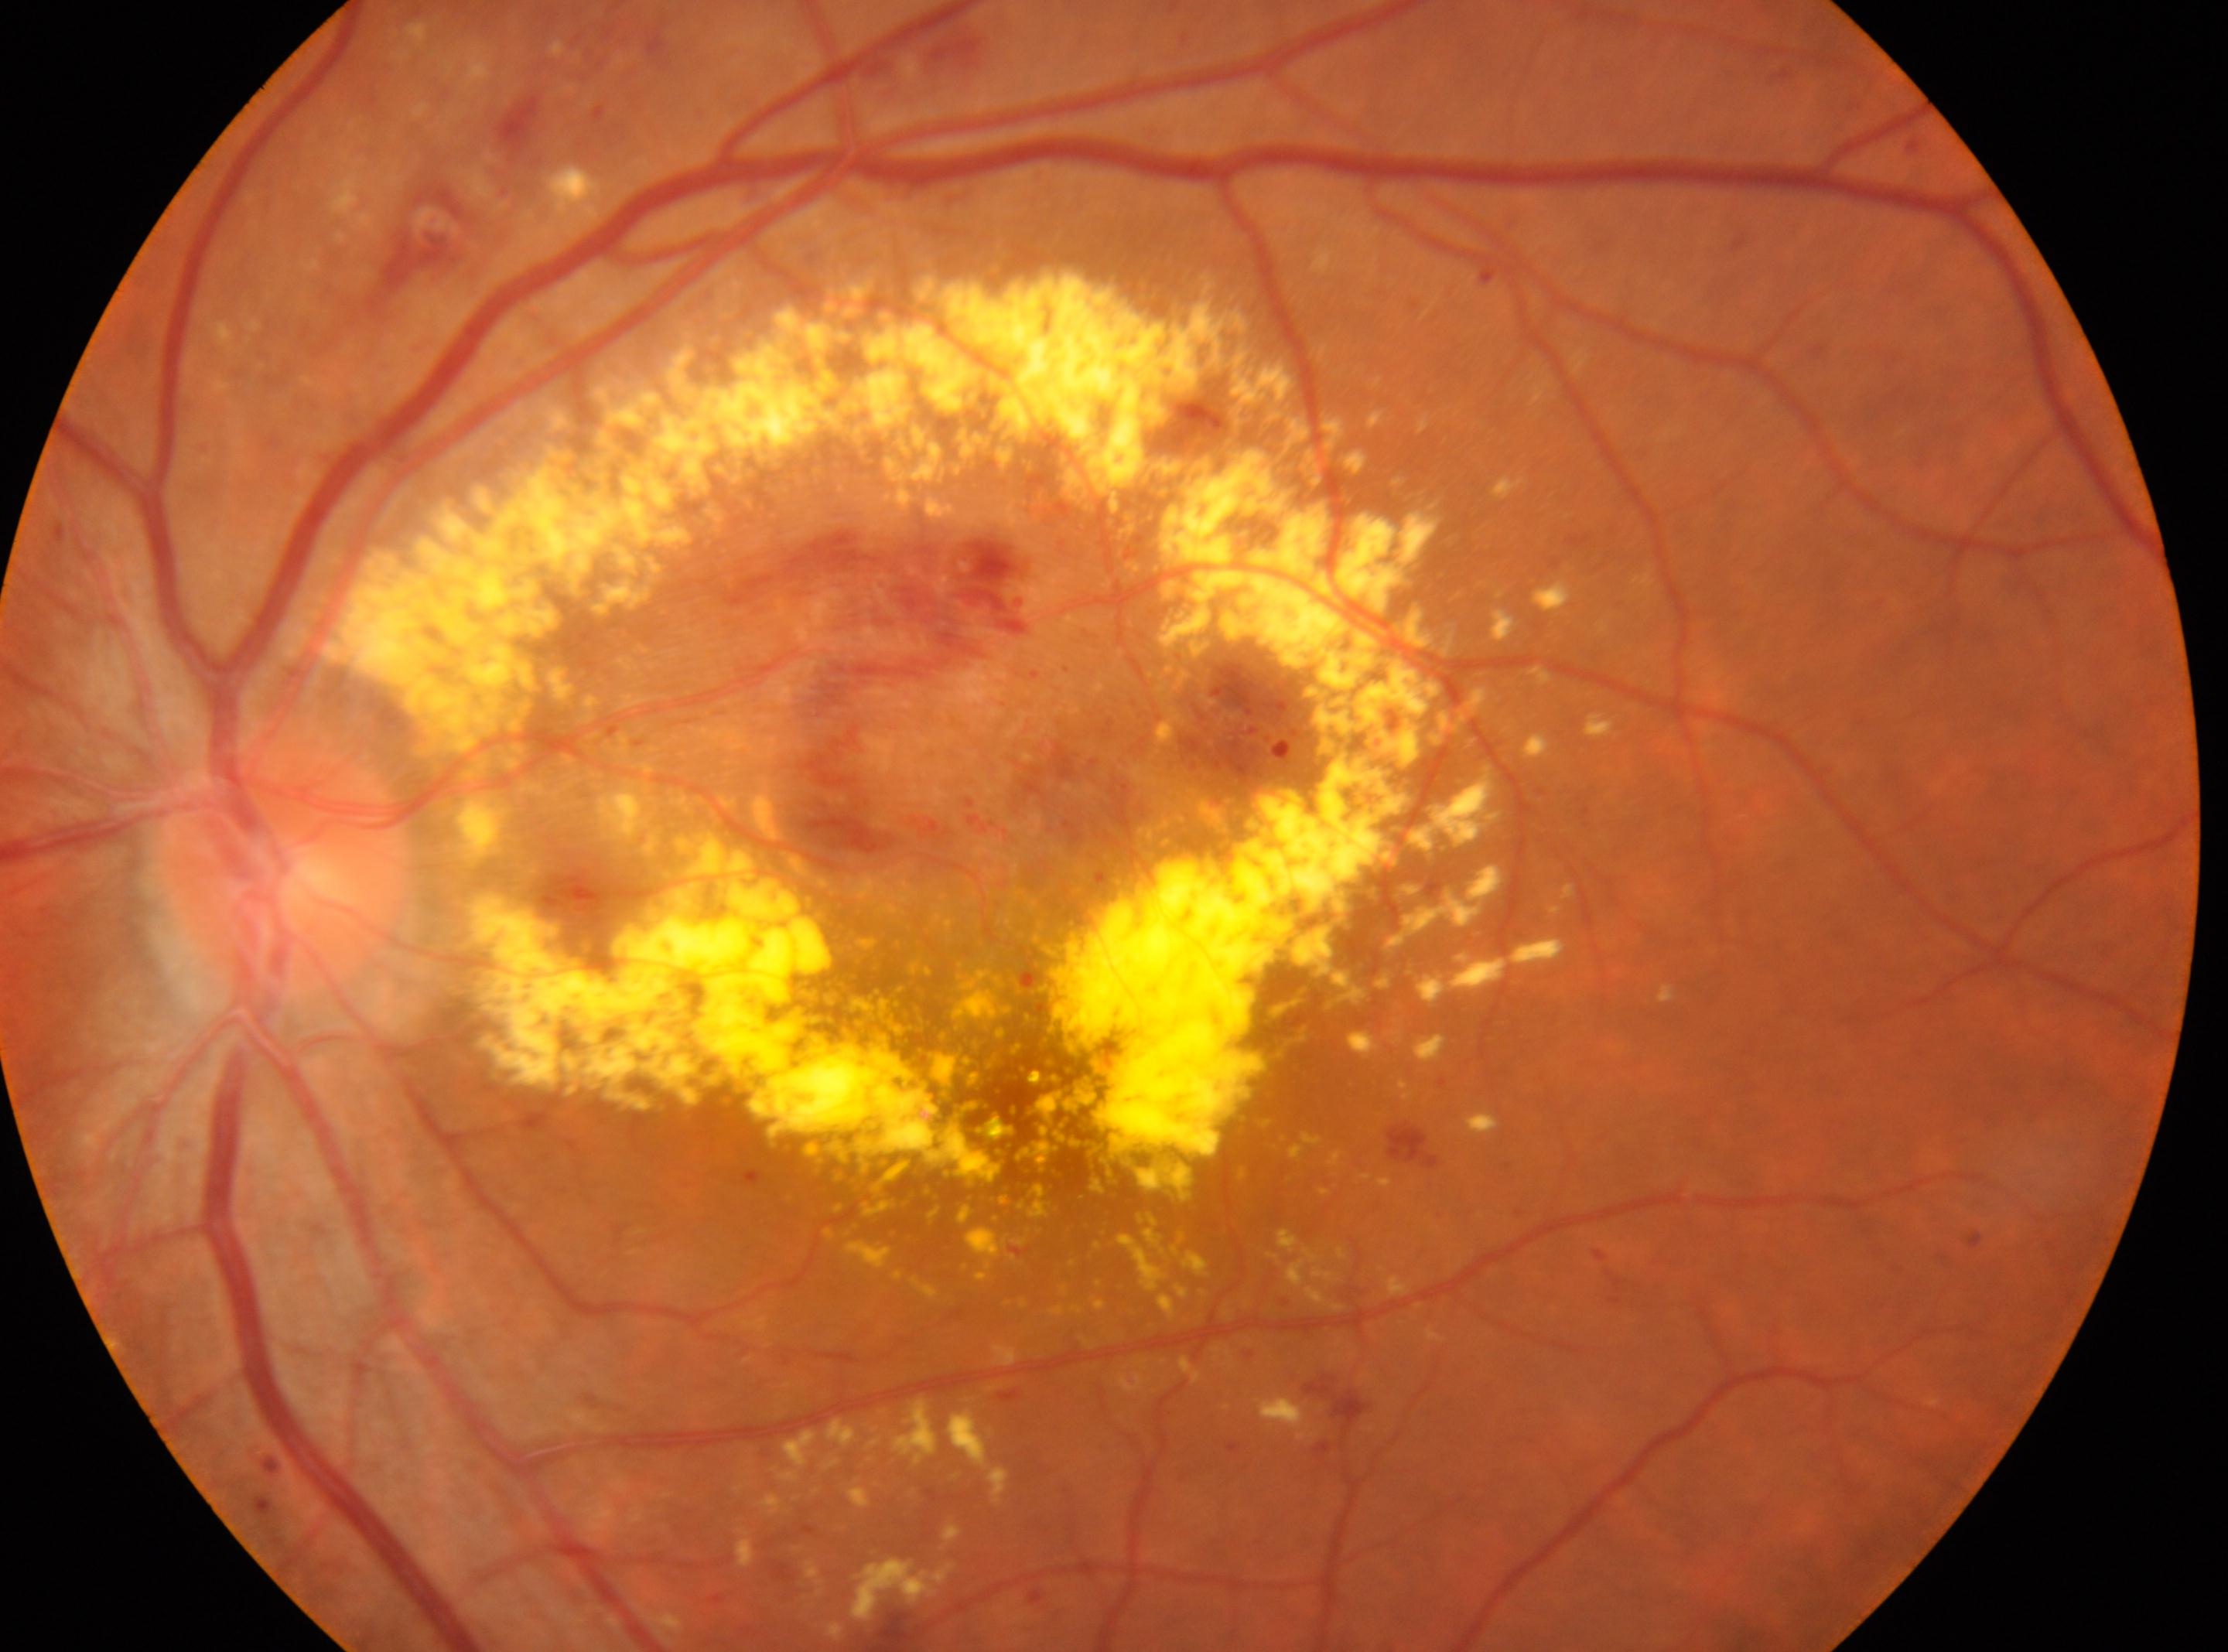

Findings:
• optic disc · (282, 871)
• diabetic retinopathy severity · grade 3 (severe NPDR)
• laterality · the left eye
• the fovea · (1013, 1094)